Color fundus image · FOV: 45 degrees · image size 2352x1568: 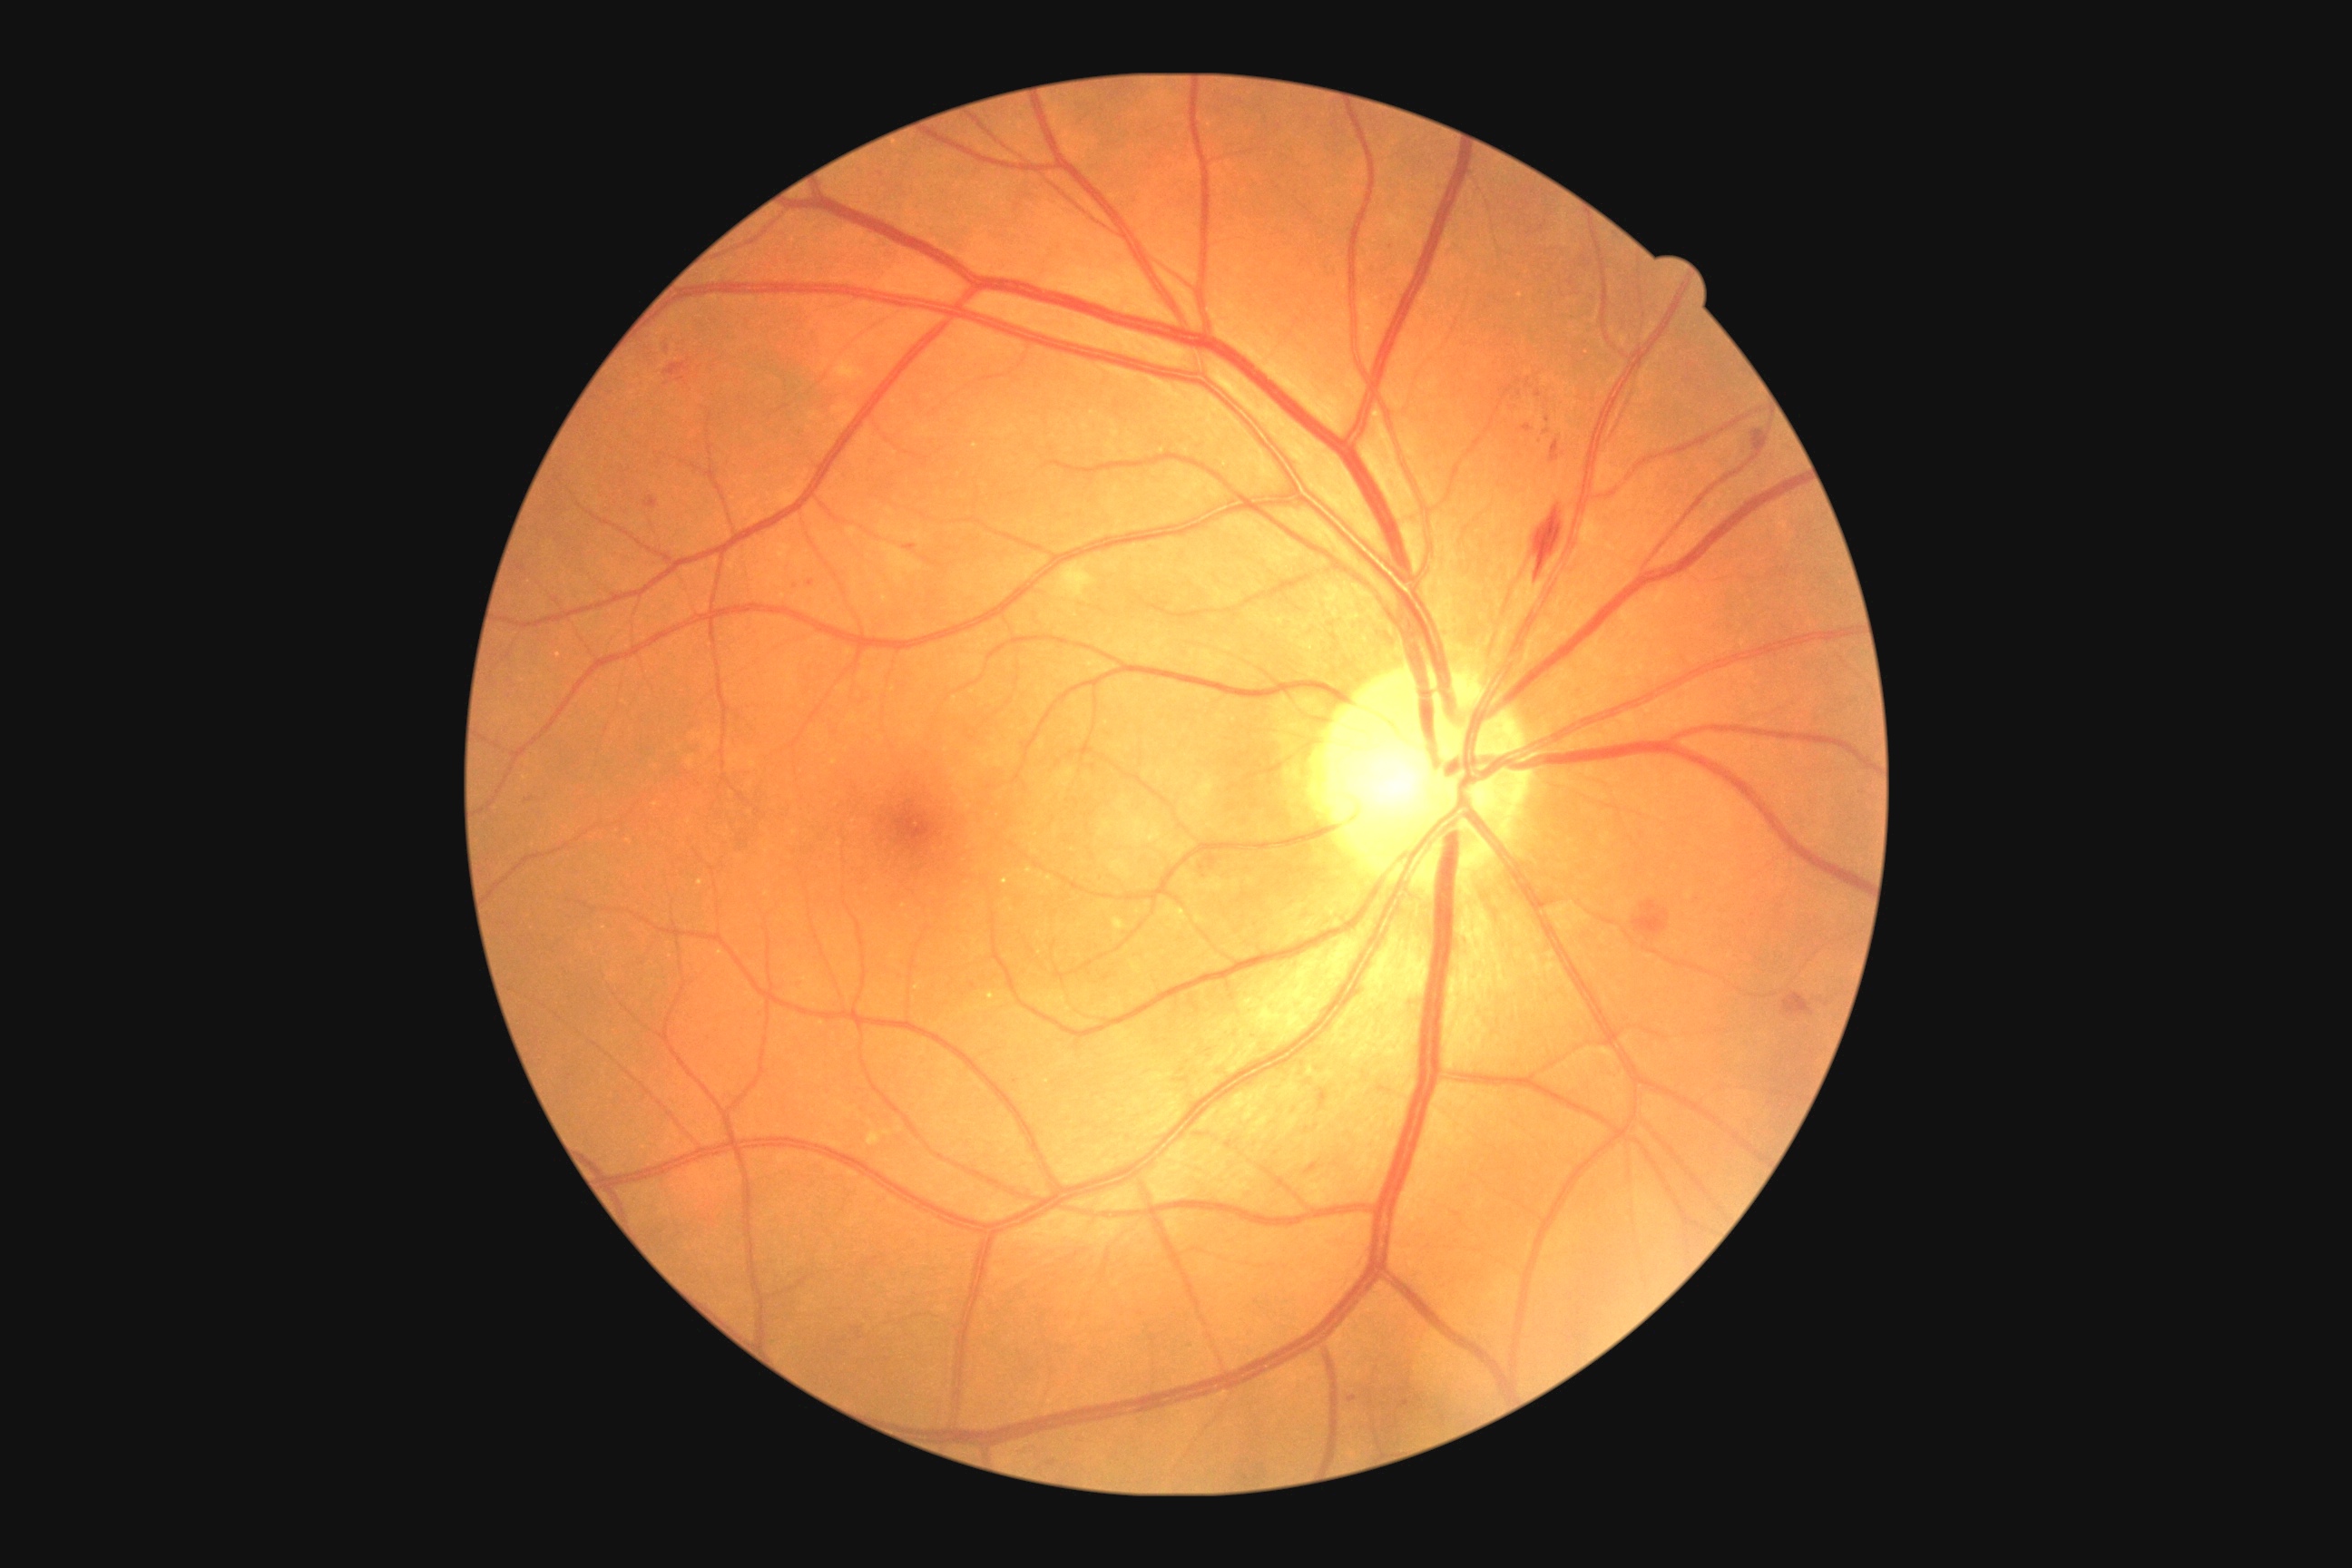

Findings:
– diabetic retinopathy (DR): grade 2 (moderate NPDR)